240 by 240 pixels
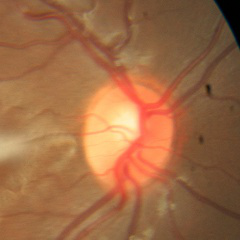

Q: Is glaucoma present?
A: No signs of glaucoma.